Without pupil dilation. Modified Davis classification
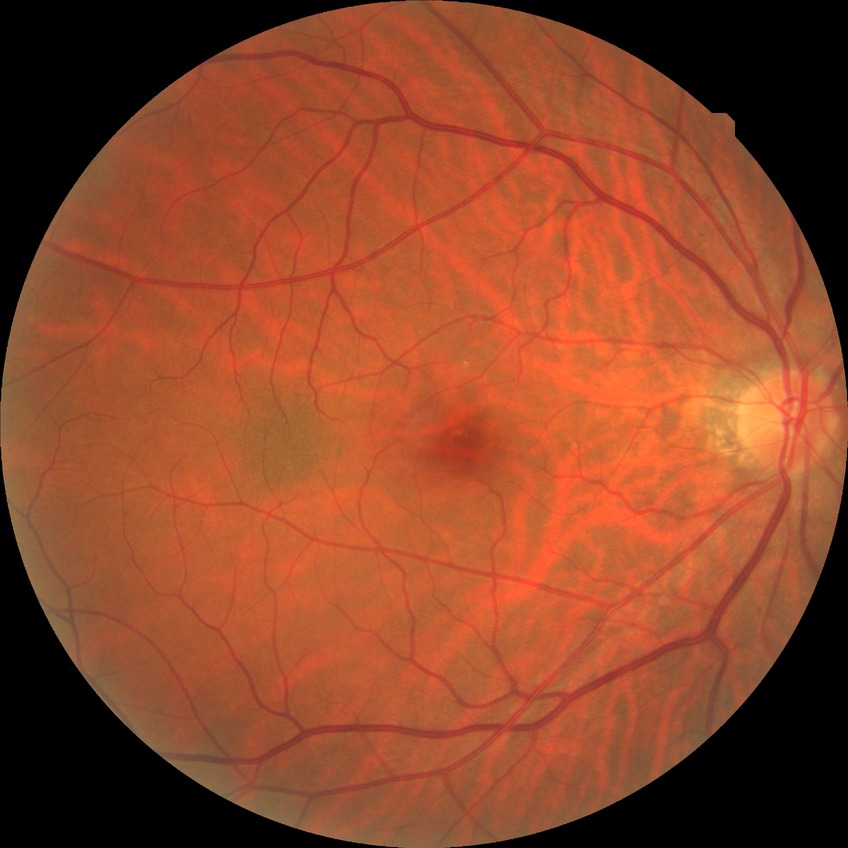 DR severity is NDR.